50° field of view, macula at the center of the field — 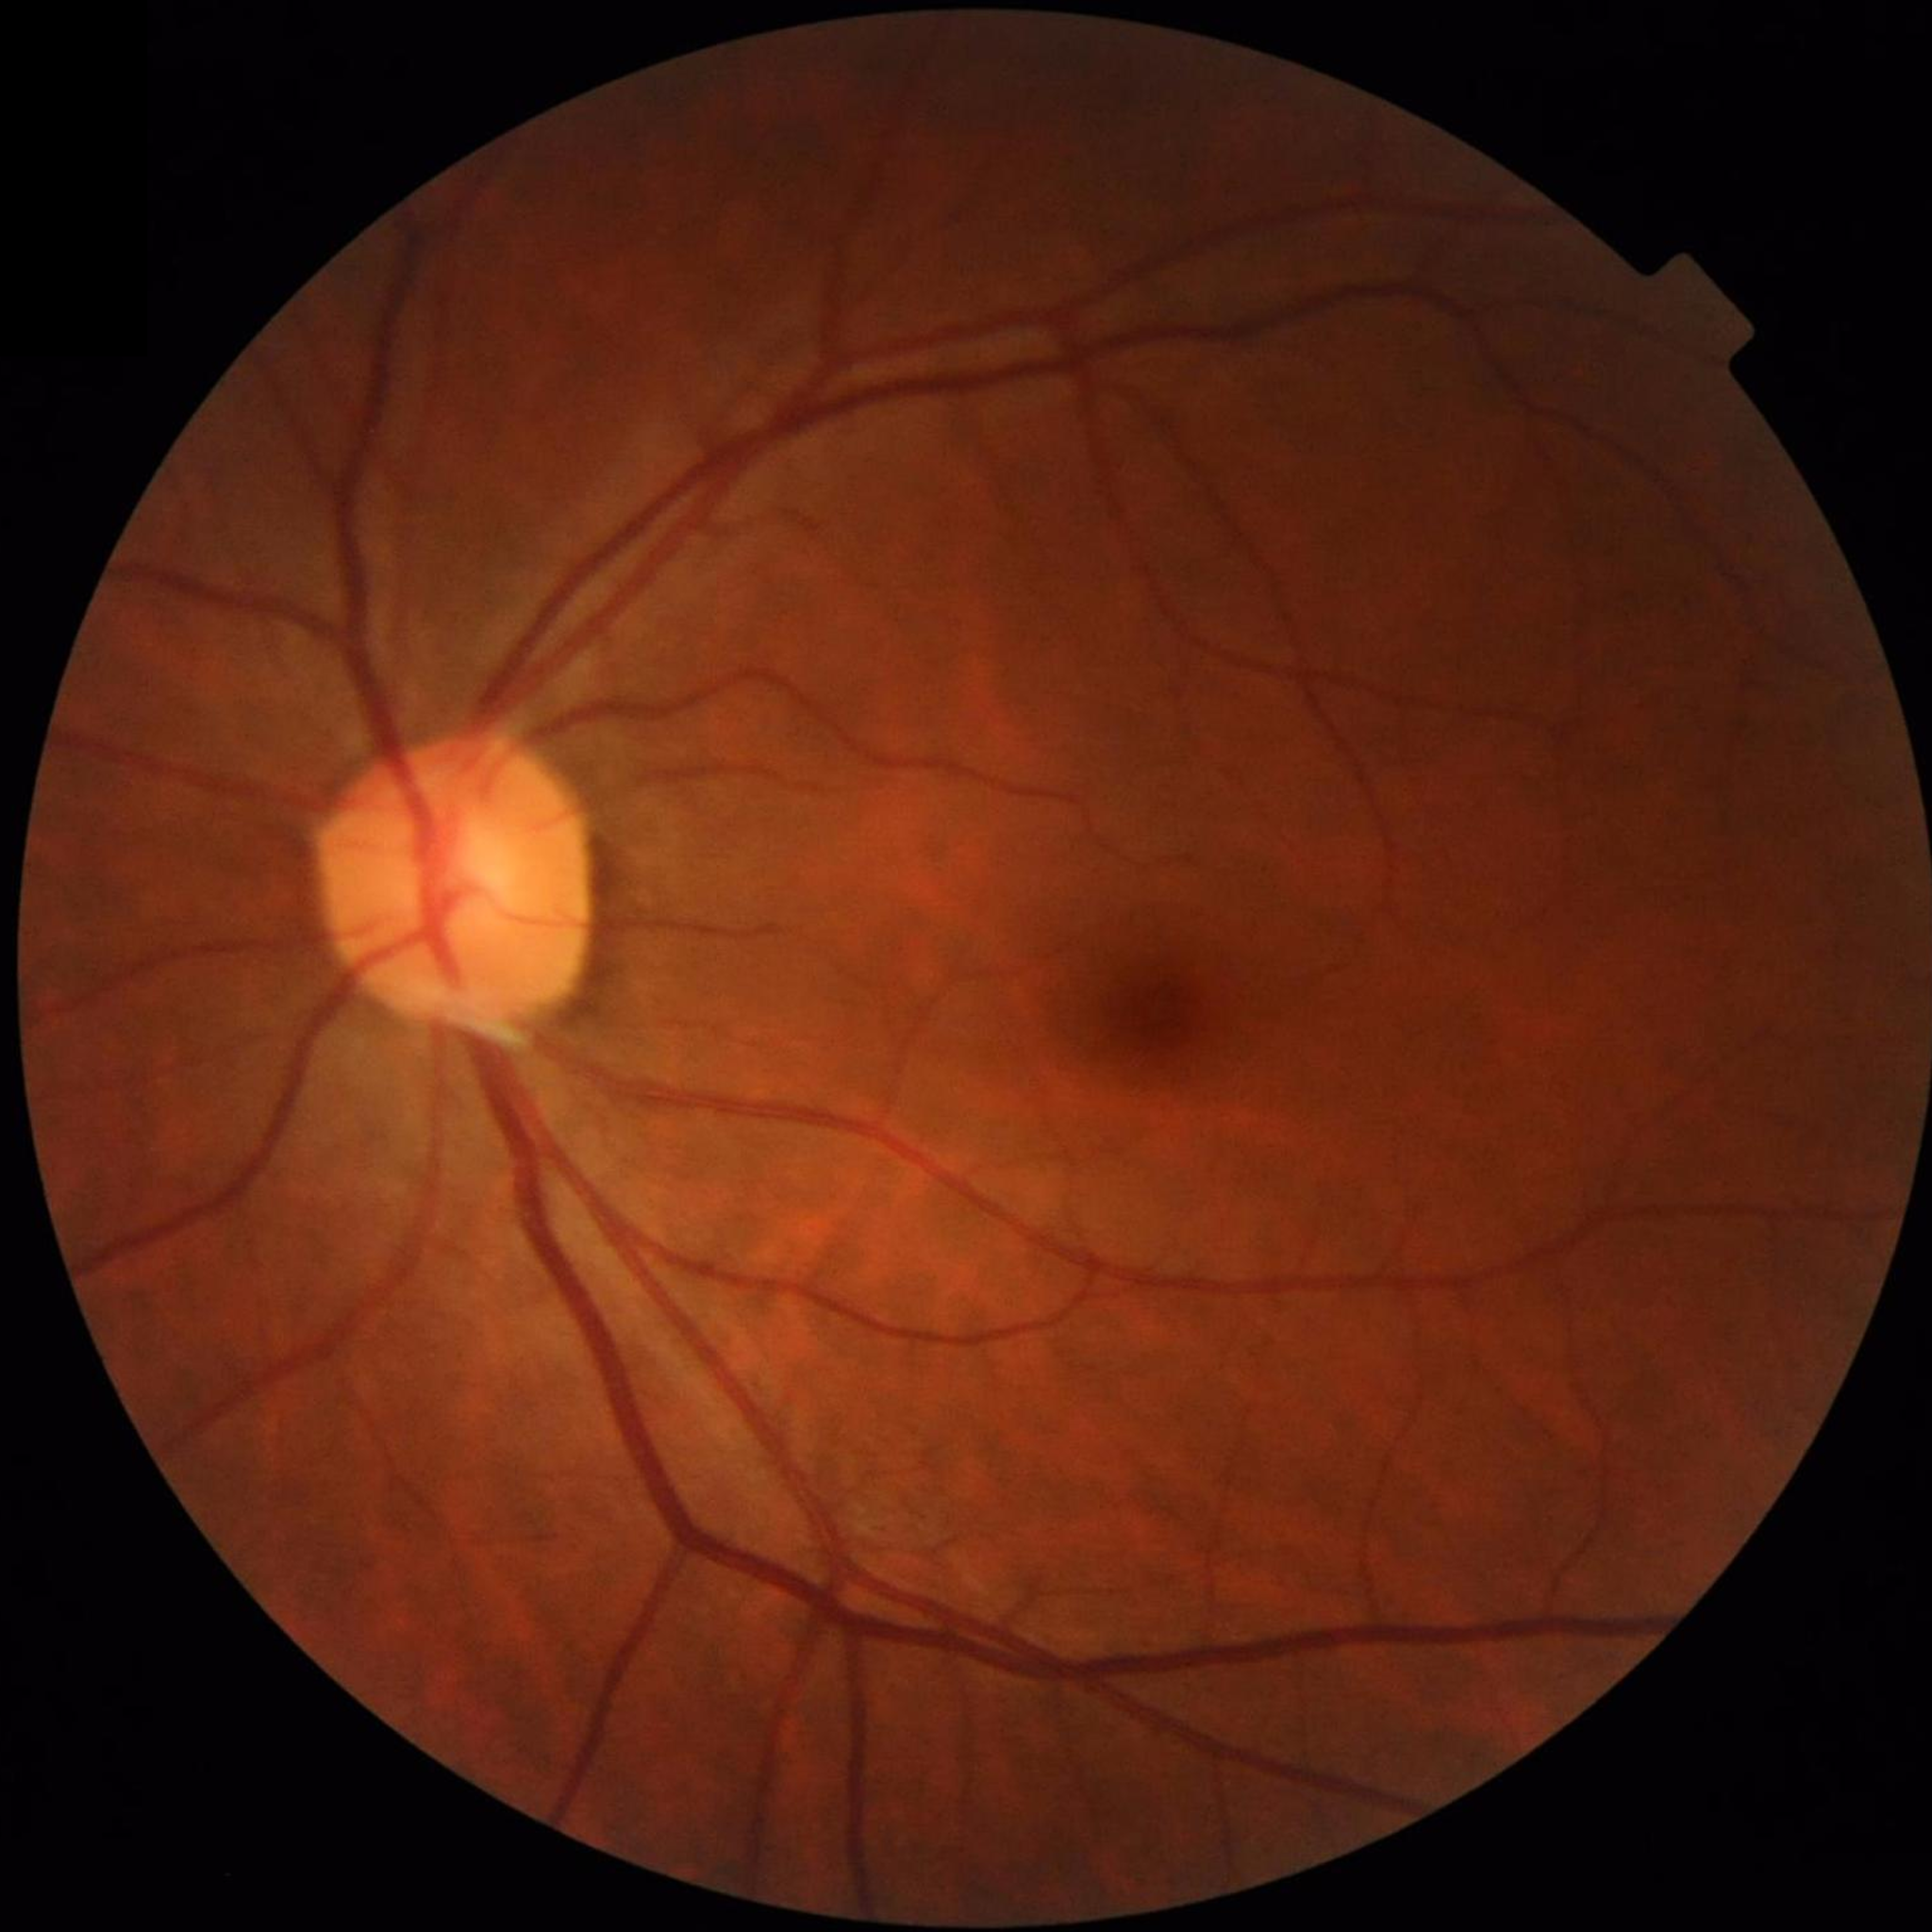
{"image_quality": "good", "diagnosis": "no AMD, DR, or glaucoma"}